Modified Davis grading — 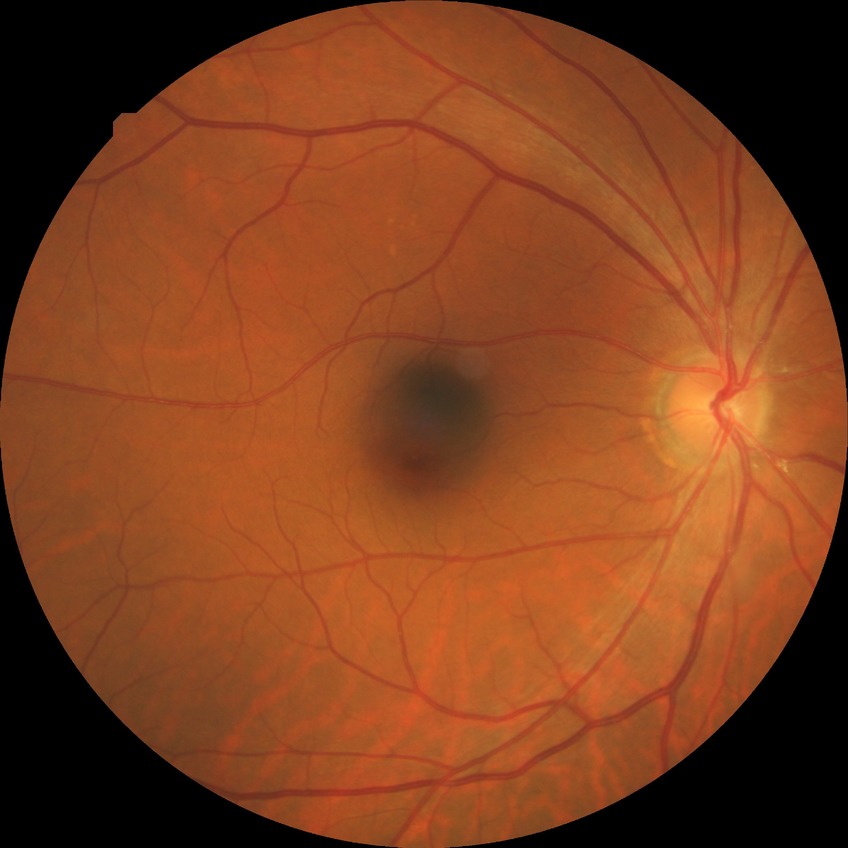

diabetic retinopathy severity = no diabetic retinopathy.